848x848; NIDEK AFC-230; CFP; 45° field of view: 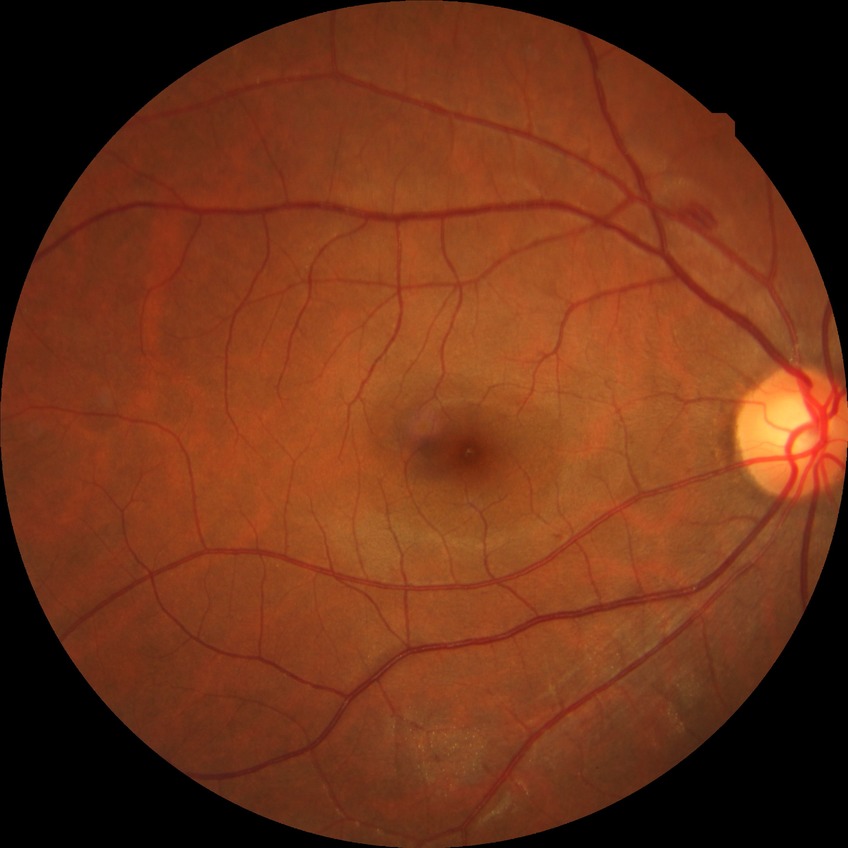

DR: NDR.